Camera: Clarity RetCam 3 (130° FOV) · pediatric wide-field fundus photograph · 640x480px: 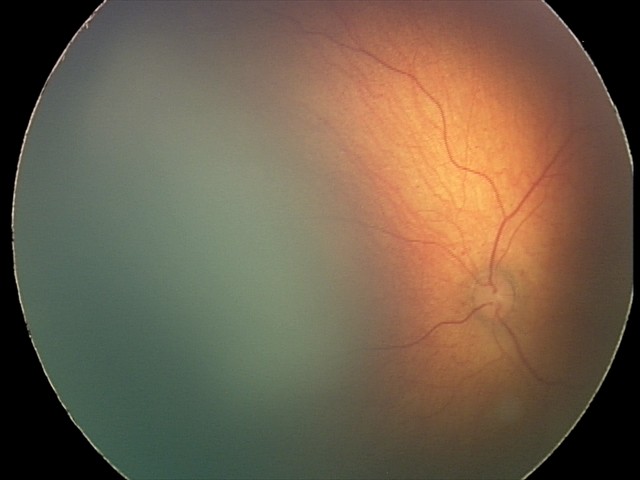 Screening examination diagnosed as physiological.